45-degree field of view — 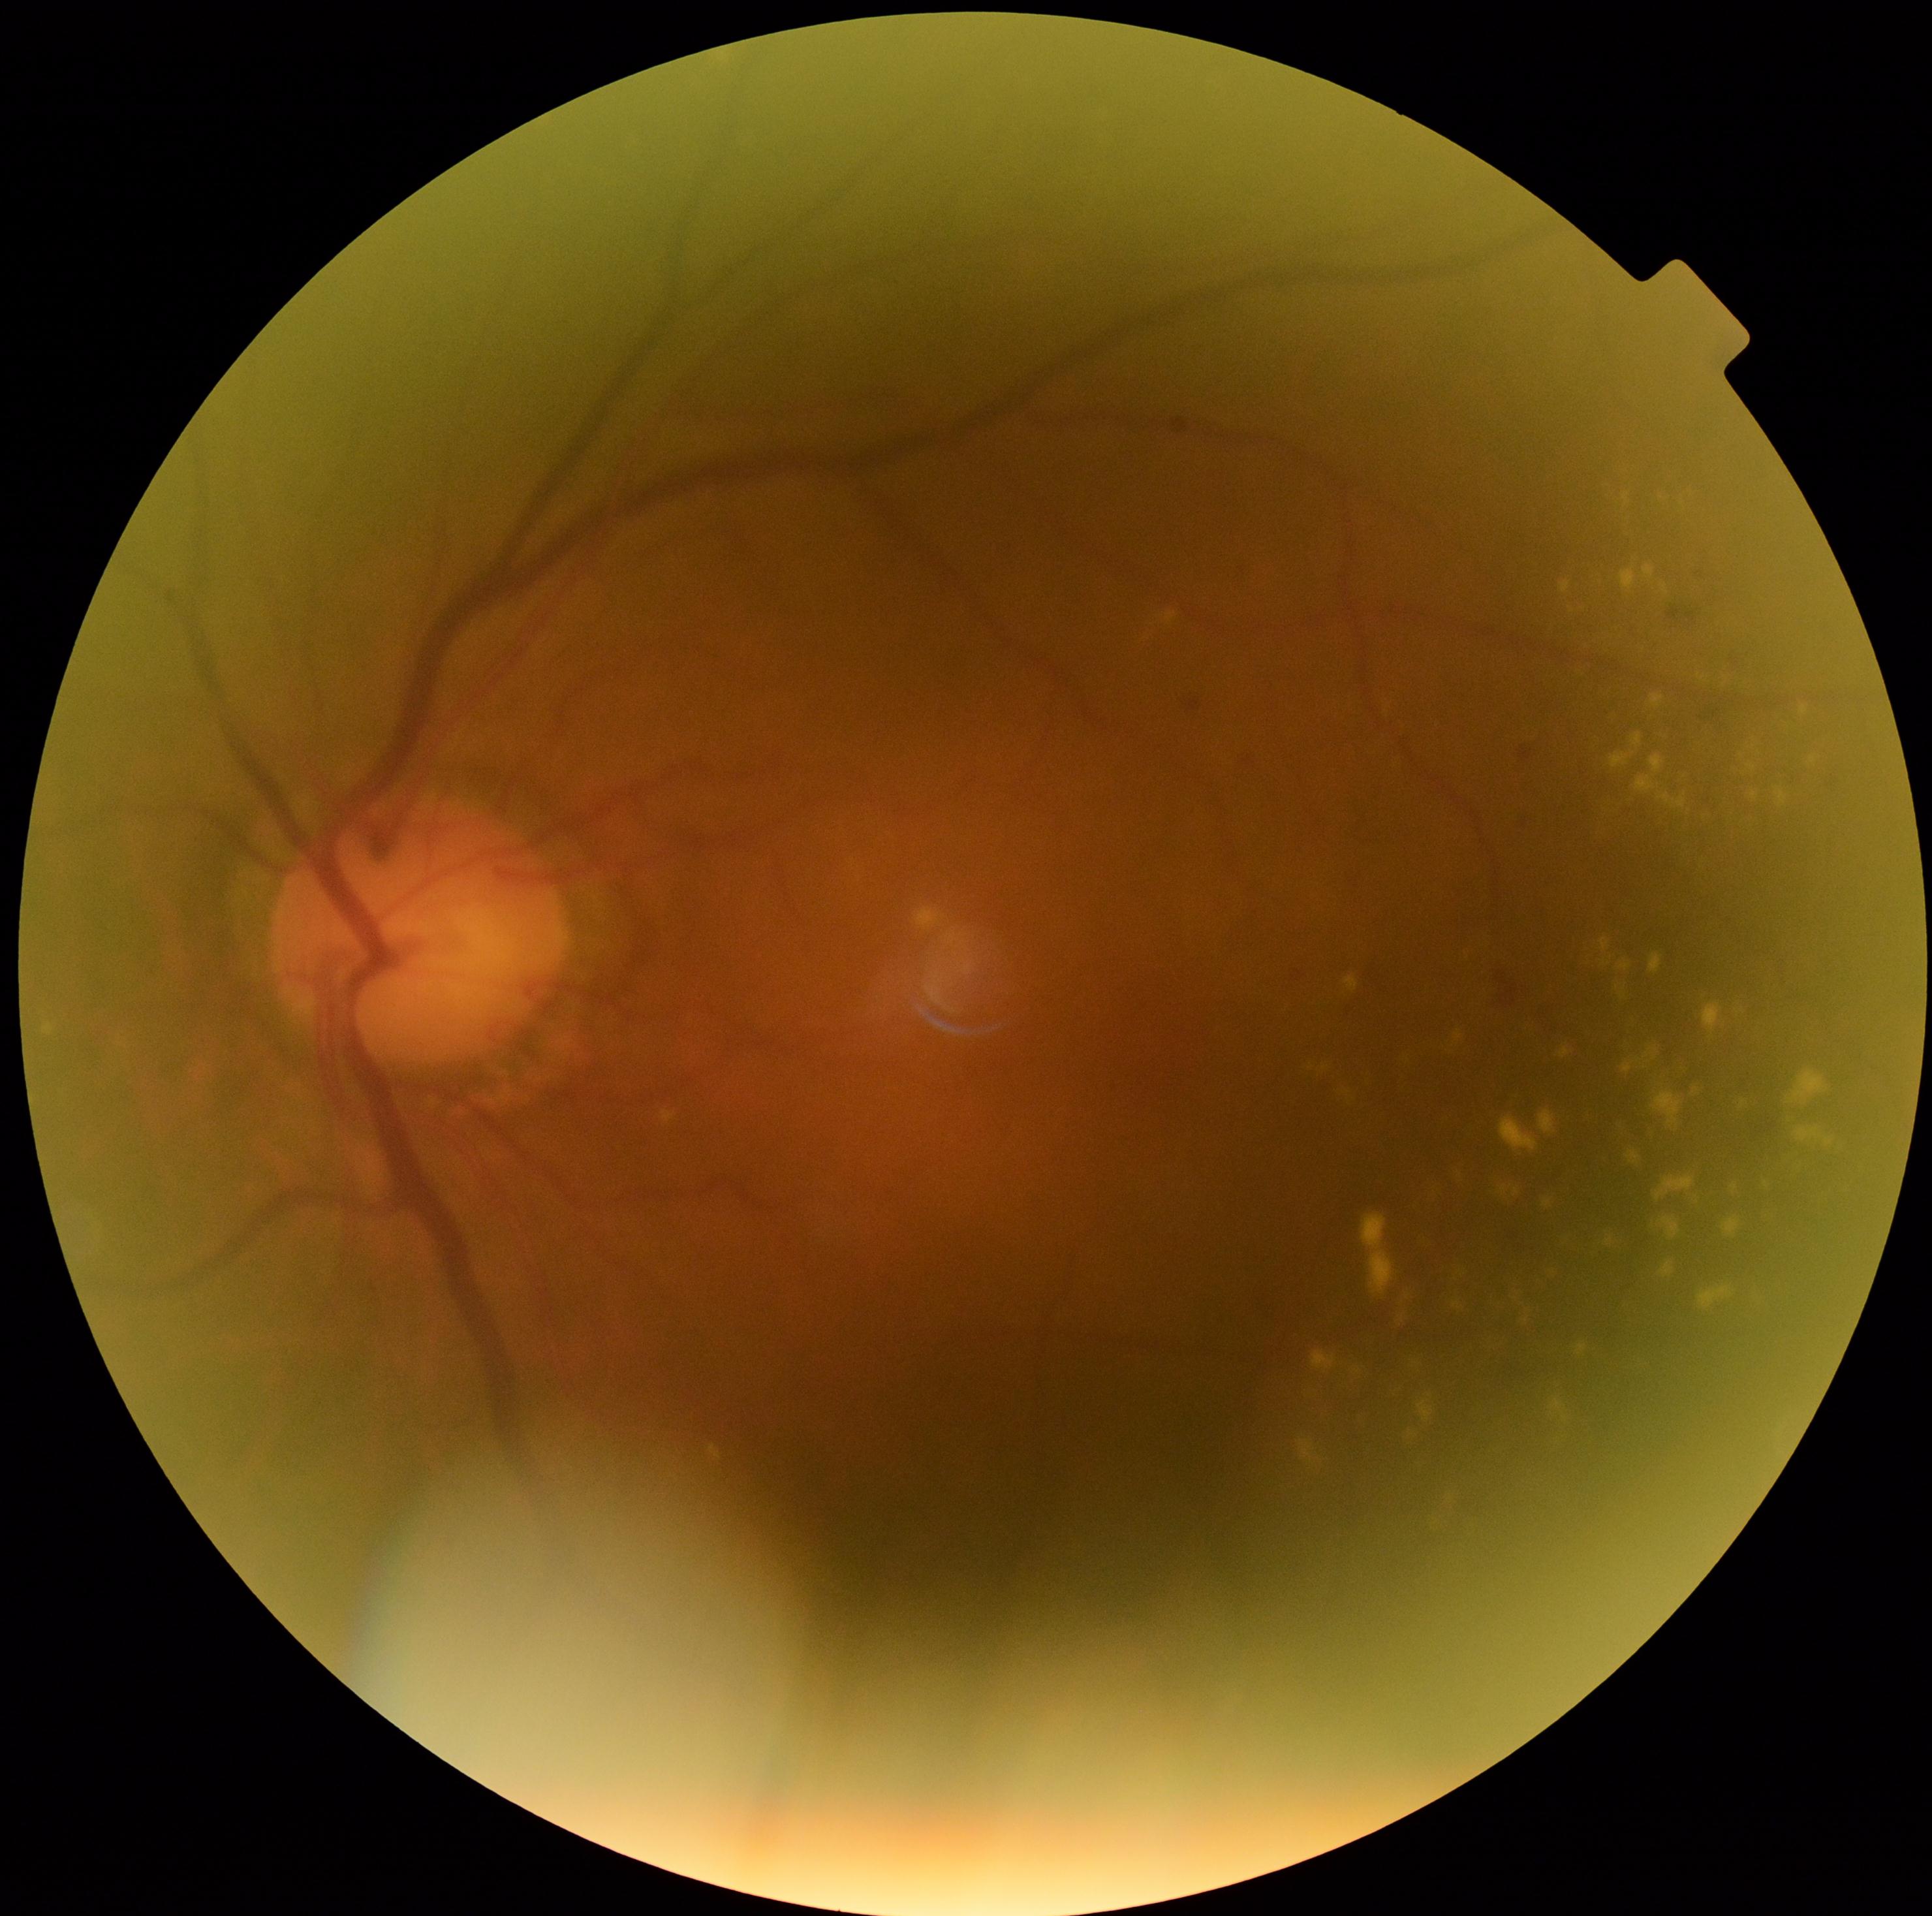

DR stage: grade 2 (moderate NPDR).